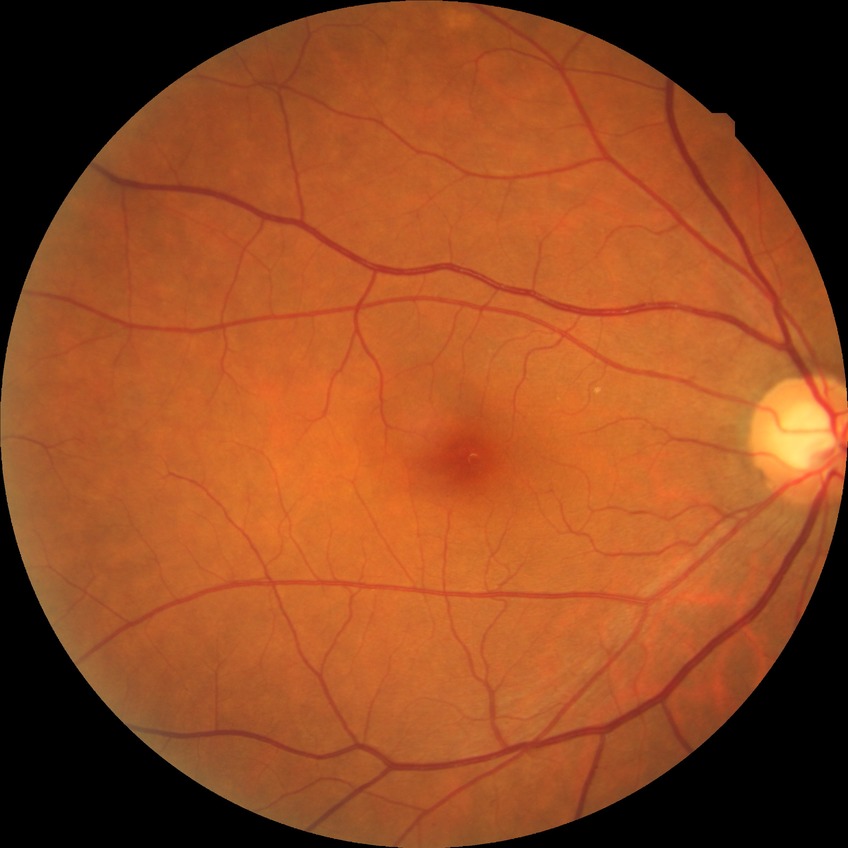 Modified Davis grading is no diabetic retinopathy.